848 by 848 pixels; nonmydriatic fundus photograph; CFP.
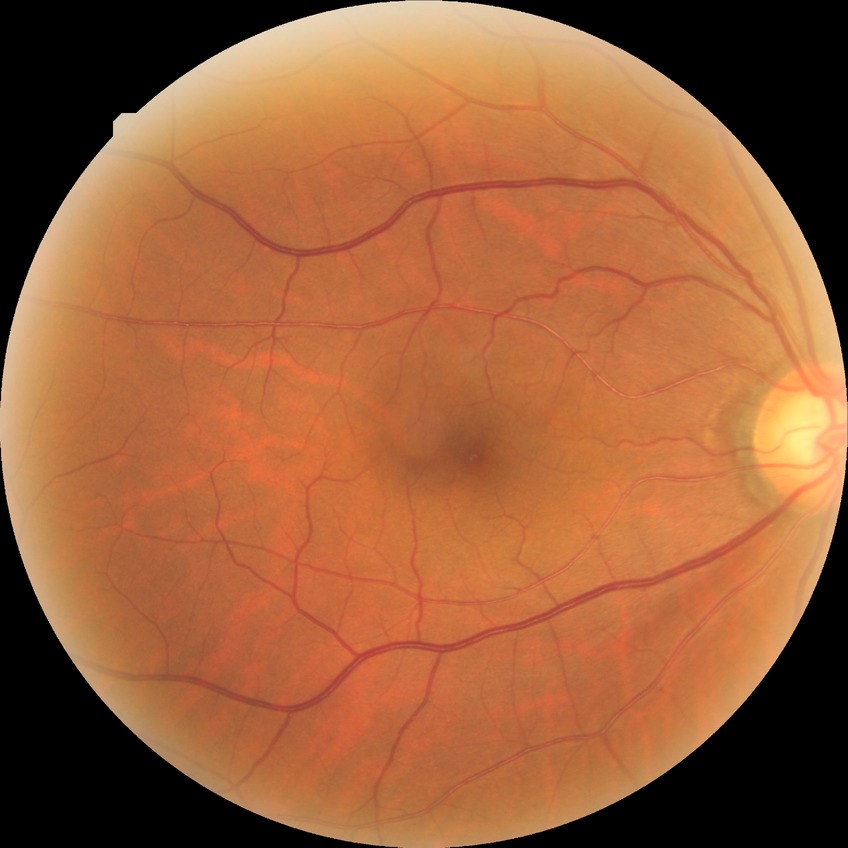

diabetic retinopathy (DR)@no diabetic retinopathy (NDR).